Color fundus photograph, 45° field of view.
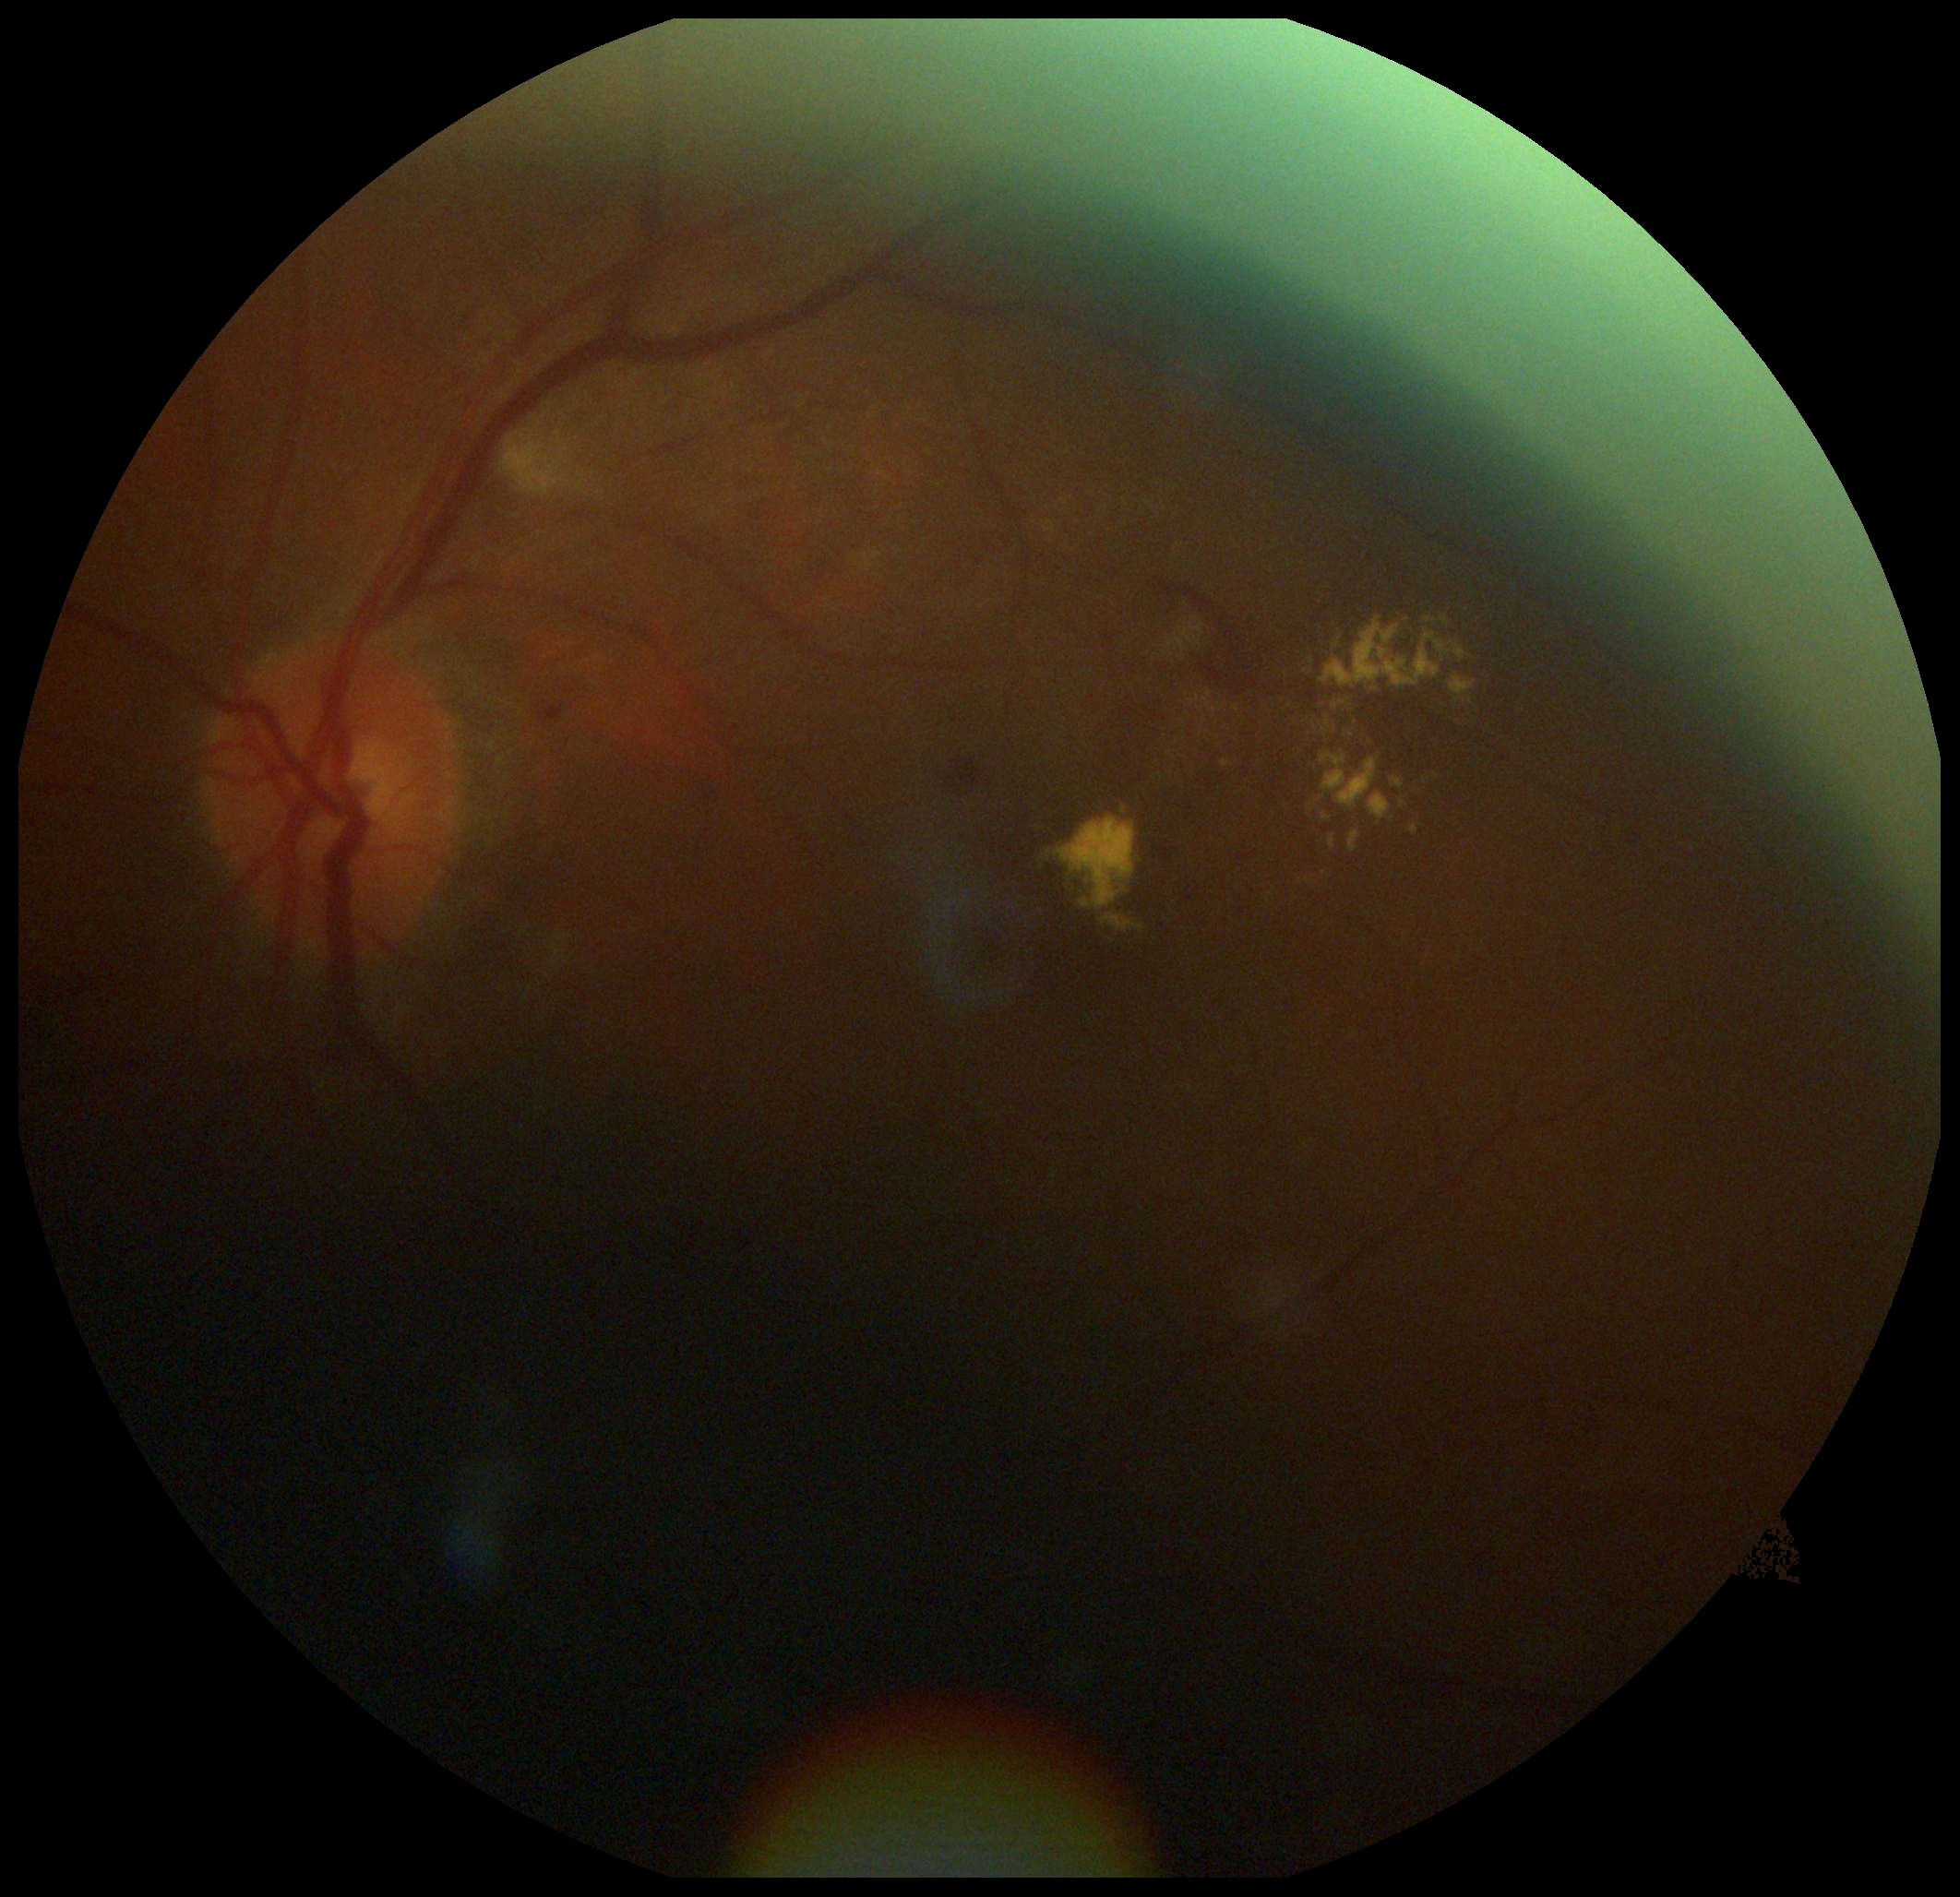 DR class: non-proliferative diabetic retinopathy. DR stage: 2.